Image size 1440x1080; camera: Natus RetCam Envision (130° FOV); wide-field fundus photograph of an infant: 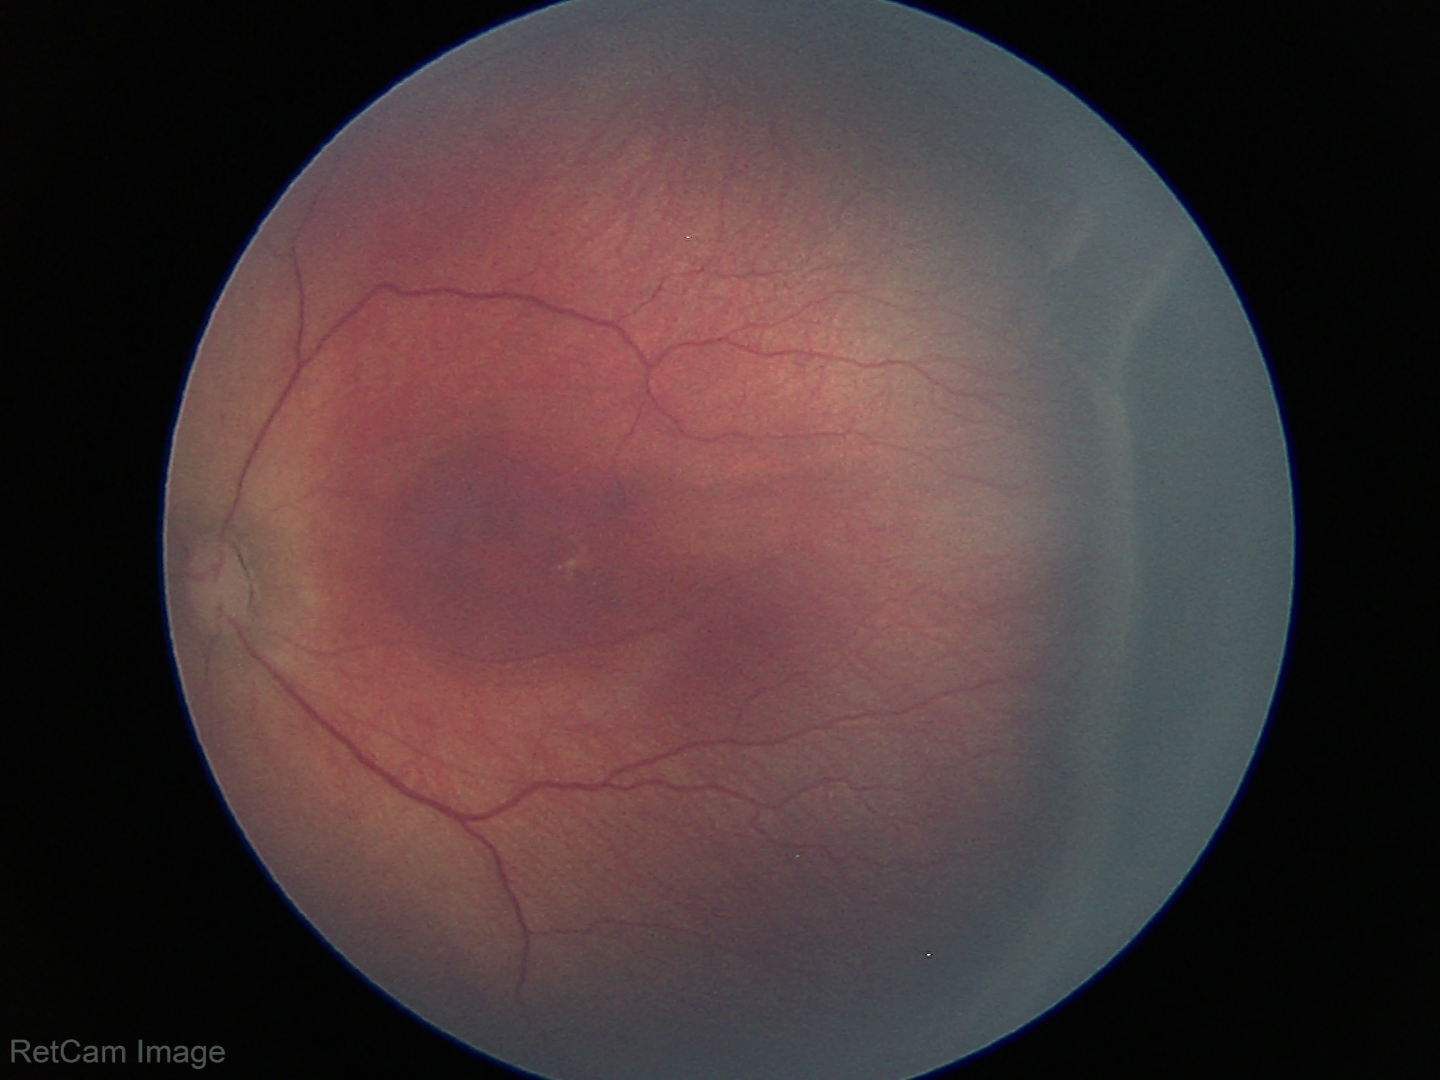
Plus disease absent. Examination diagnosed as retinopathy of prematurity (ROP) stage 3.